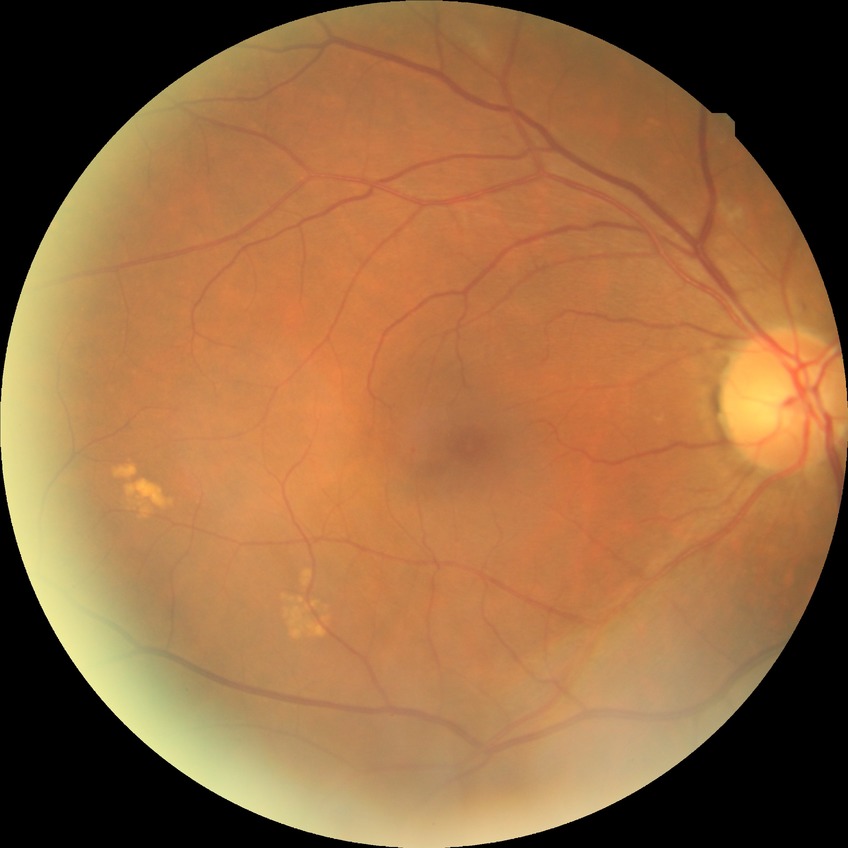 diabetic retinopathy (DR): NDR (no diabetic retinopathy).